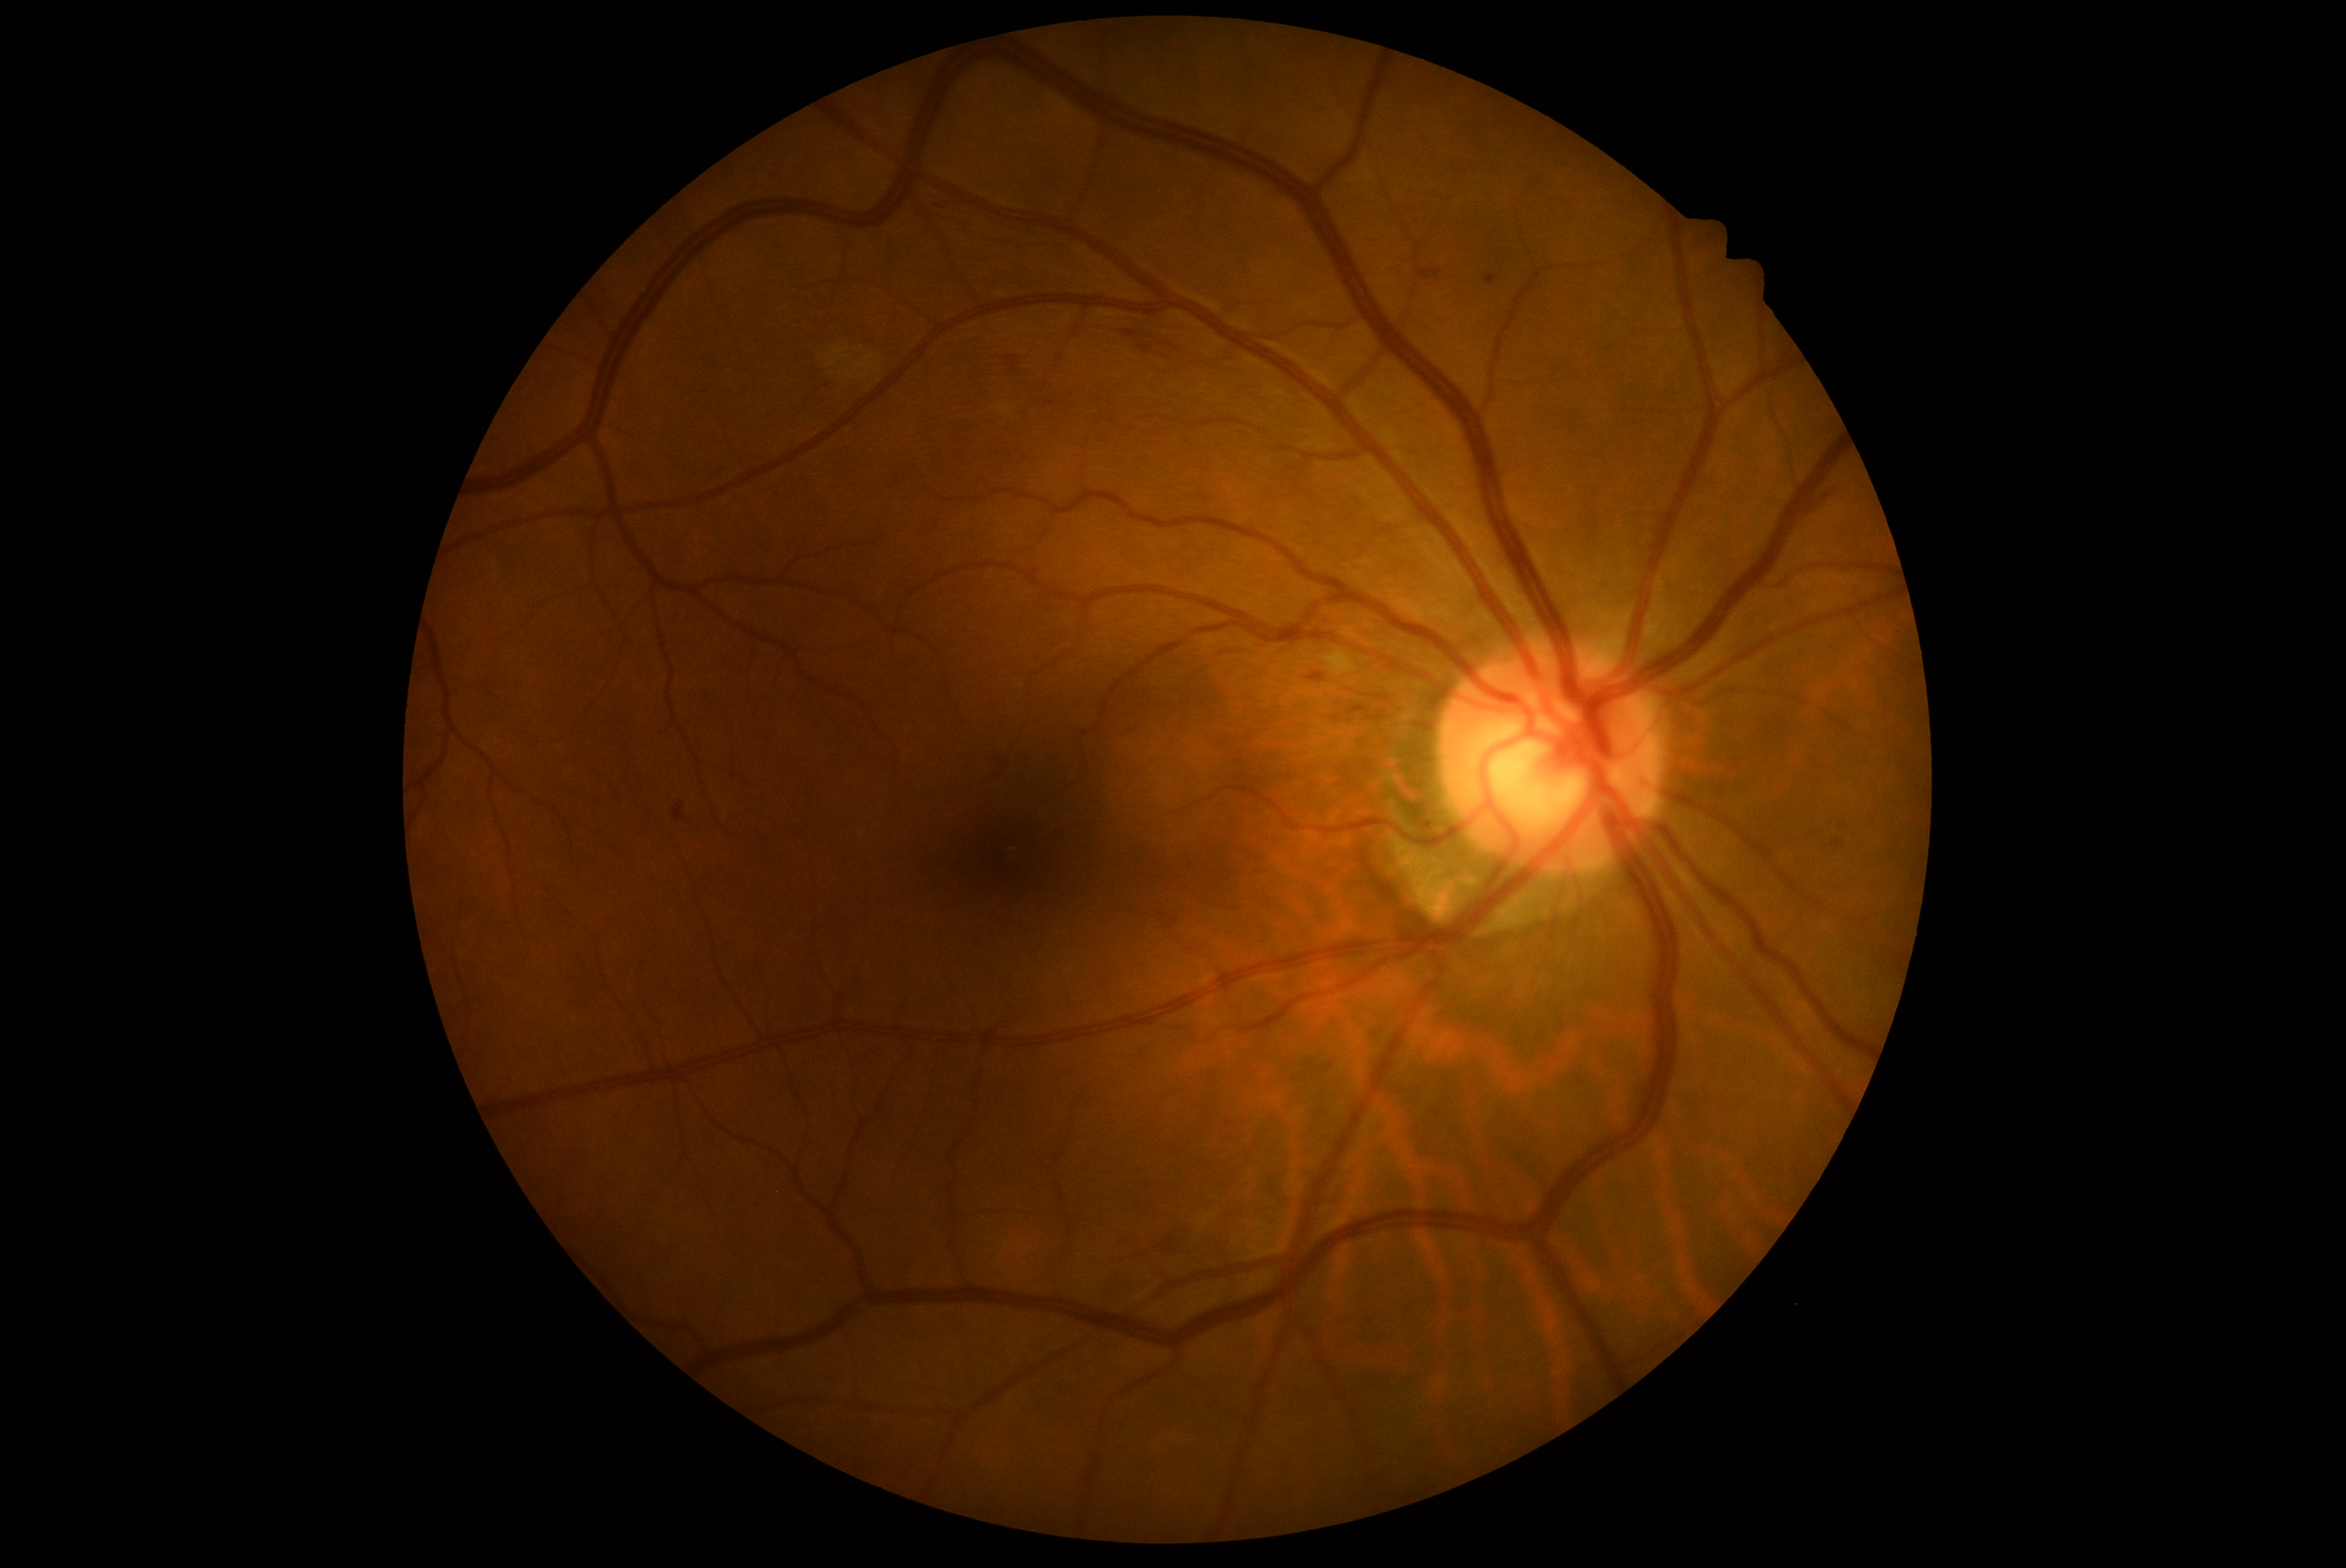 Annotations:
* diabetic retinopathy: grade 2